Optic nerve head crop.
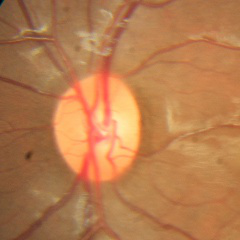 Q: What stage of glaucoma is present?
A: No glaucoma.